2048 x 1536 pixels; 45° field of view:
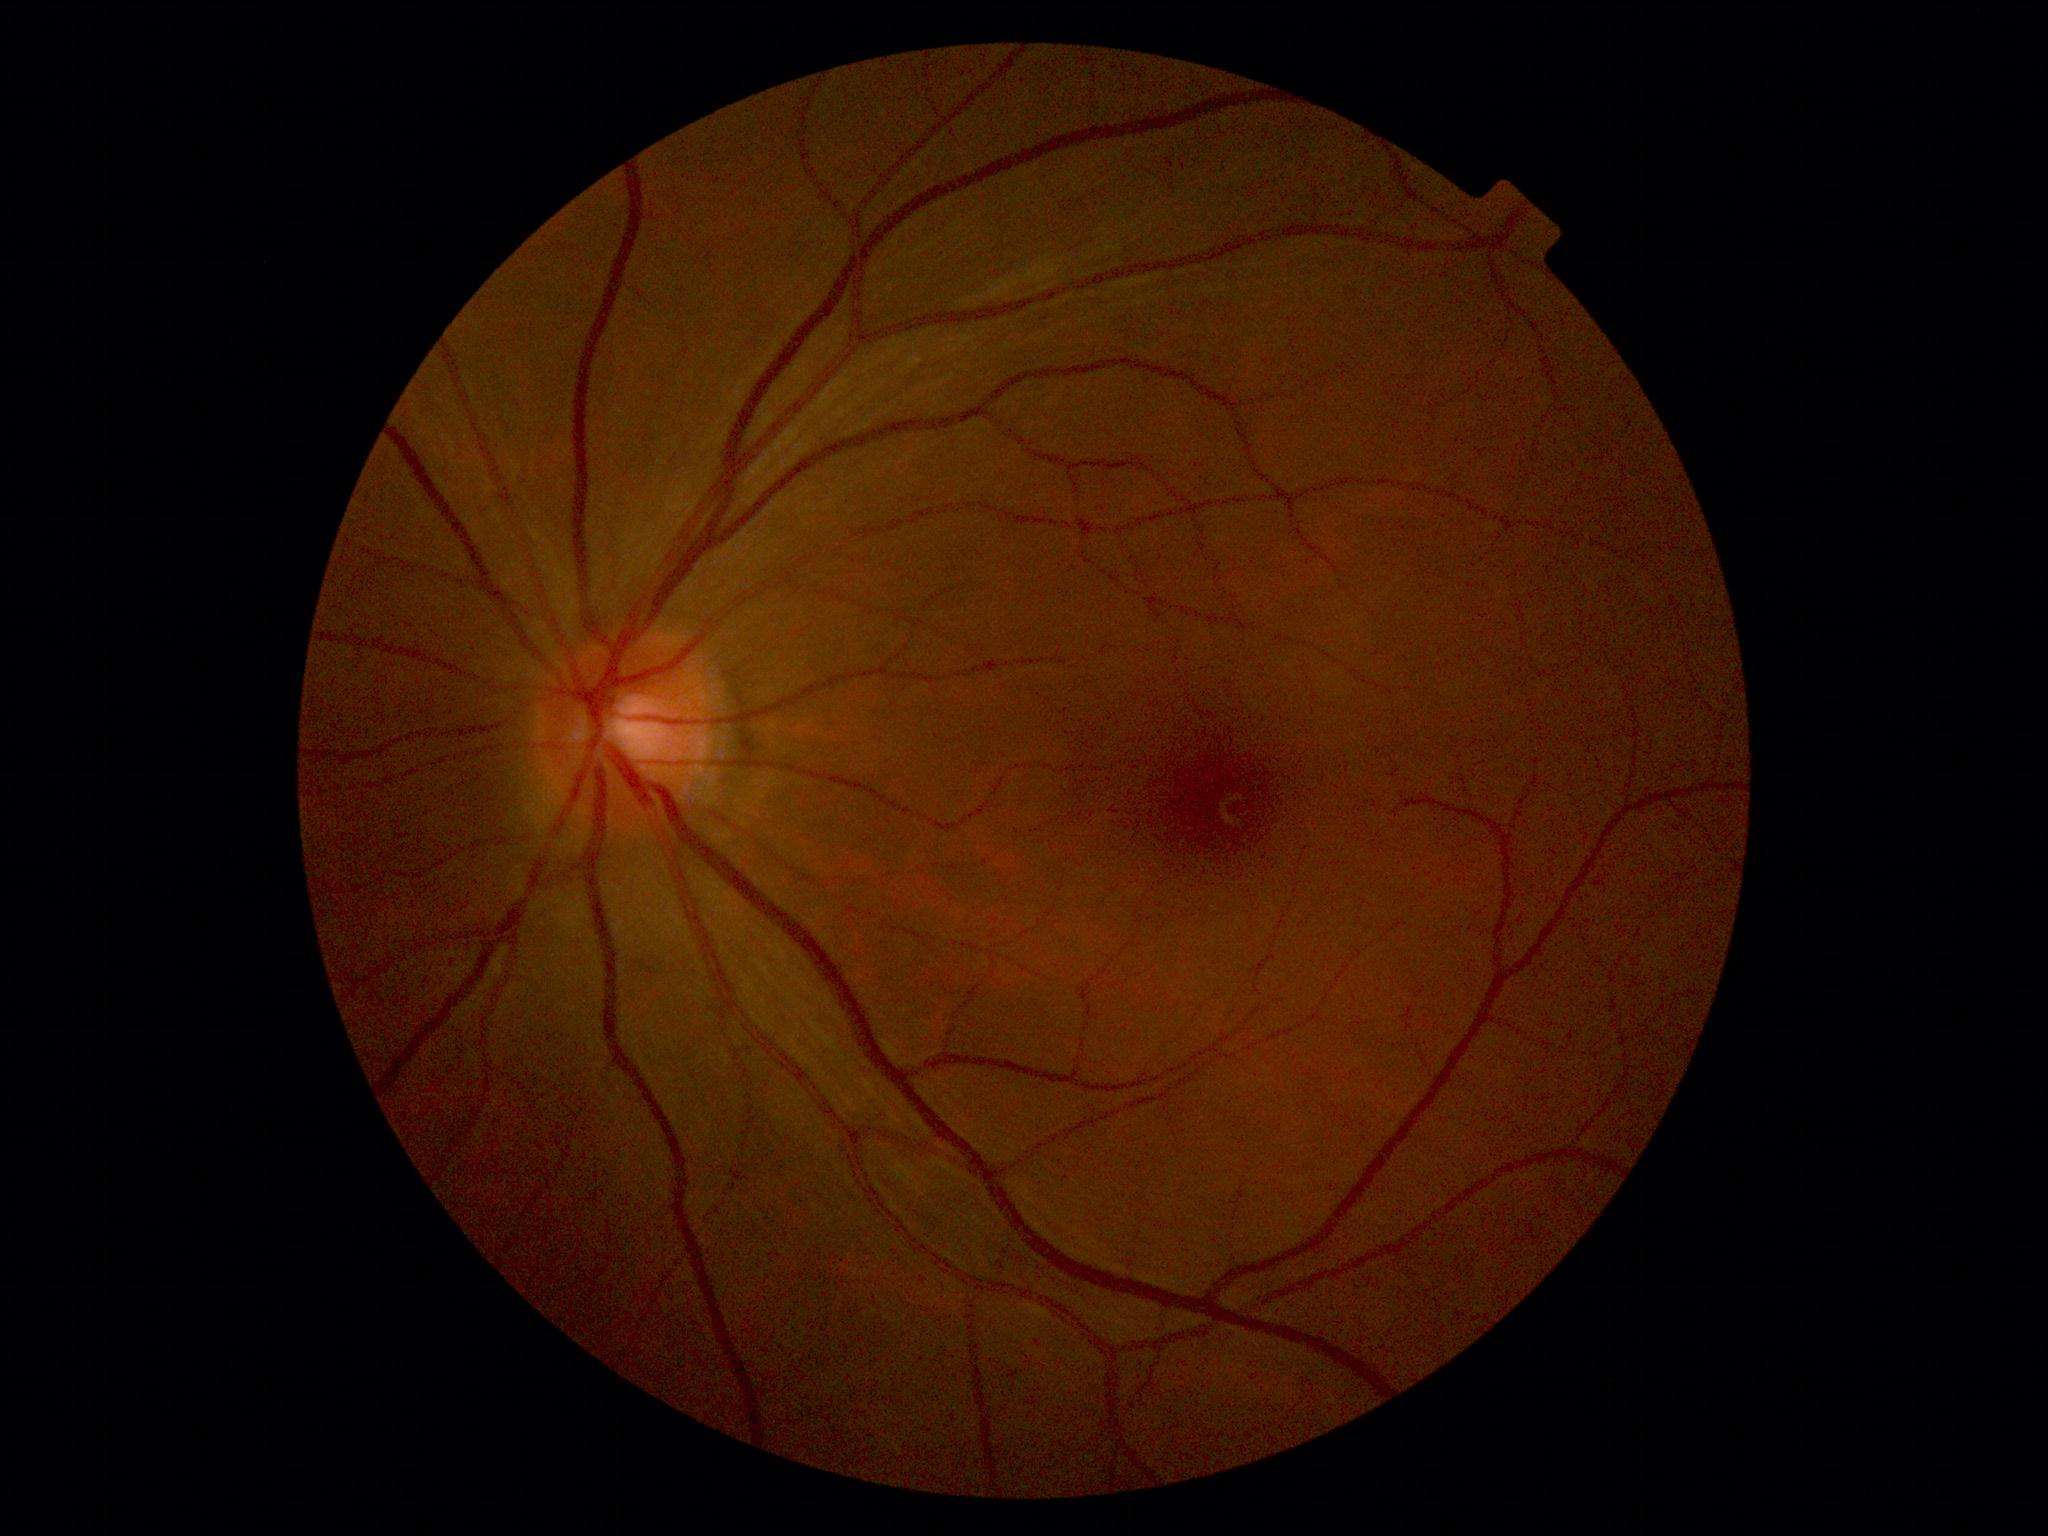
dr_grade: grade 0 (no apparent retinopathy)
dr_impression: negative for DR